Image size 2048x1536 — 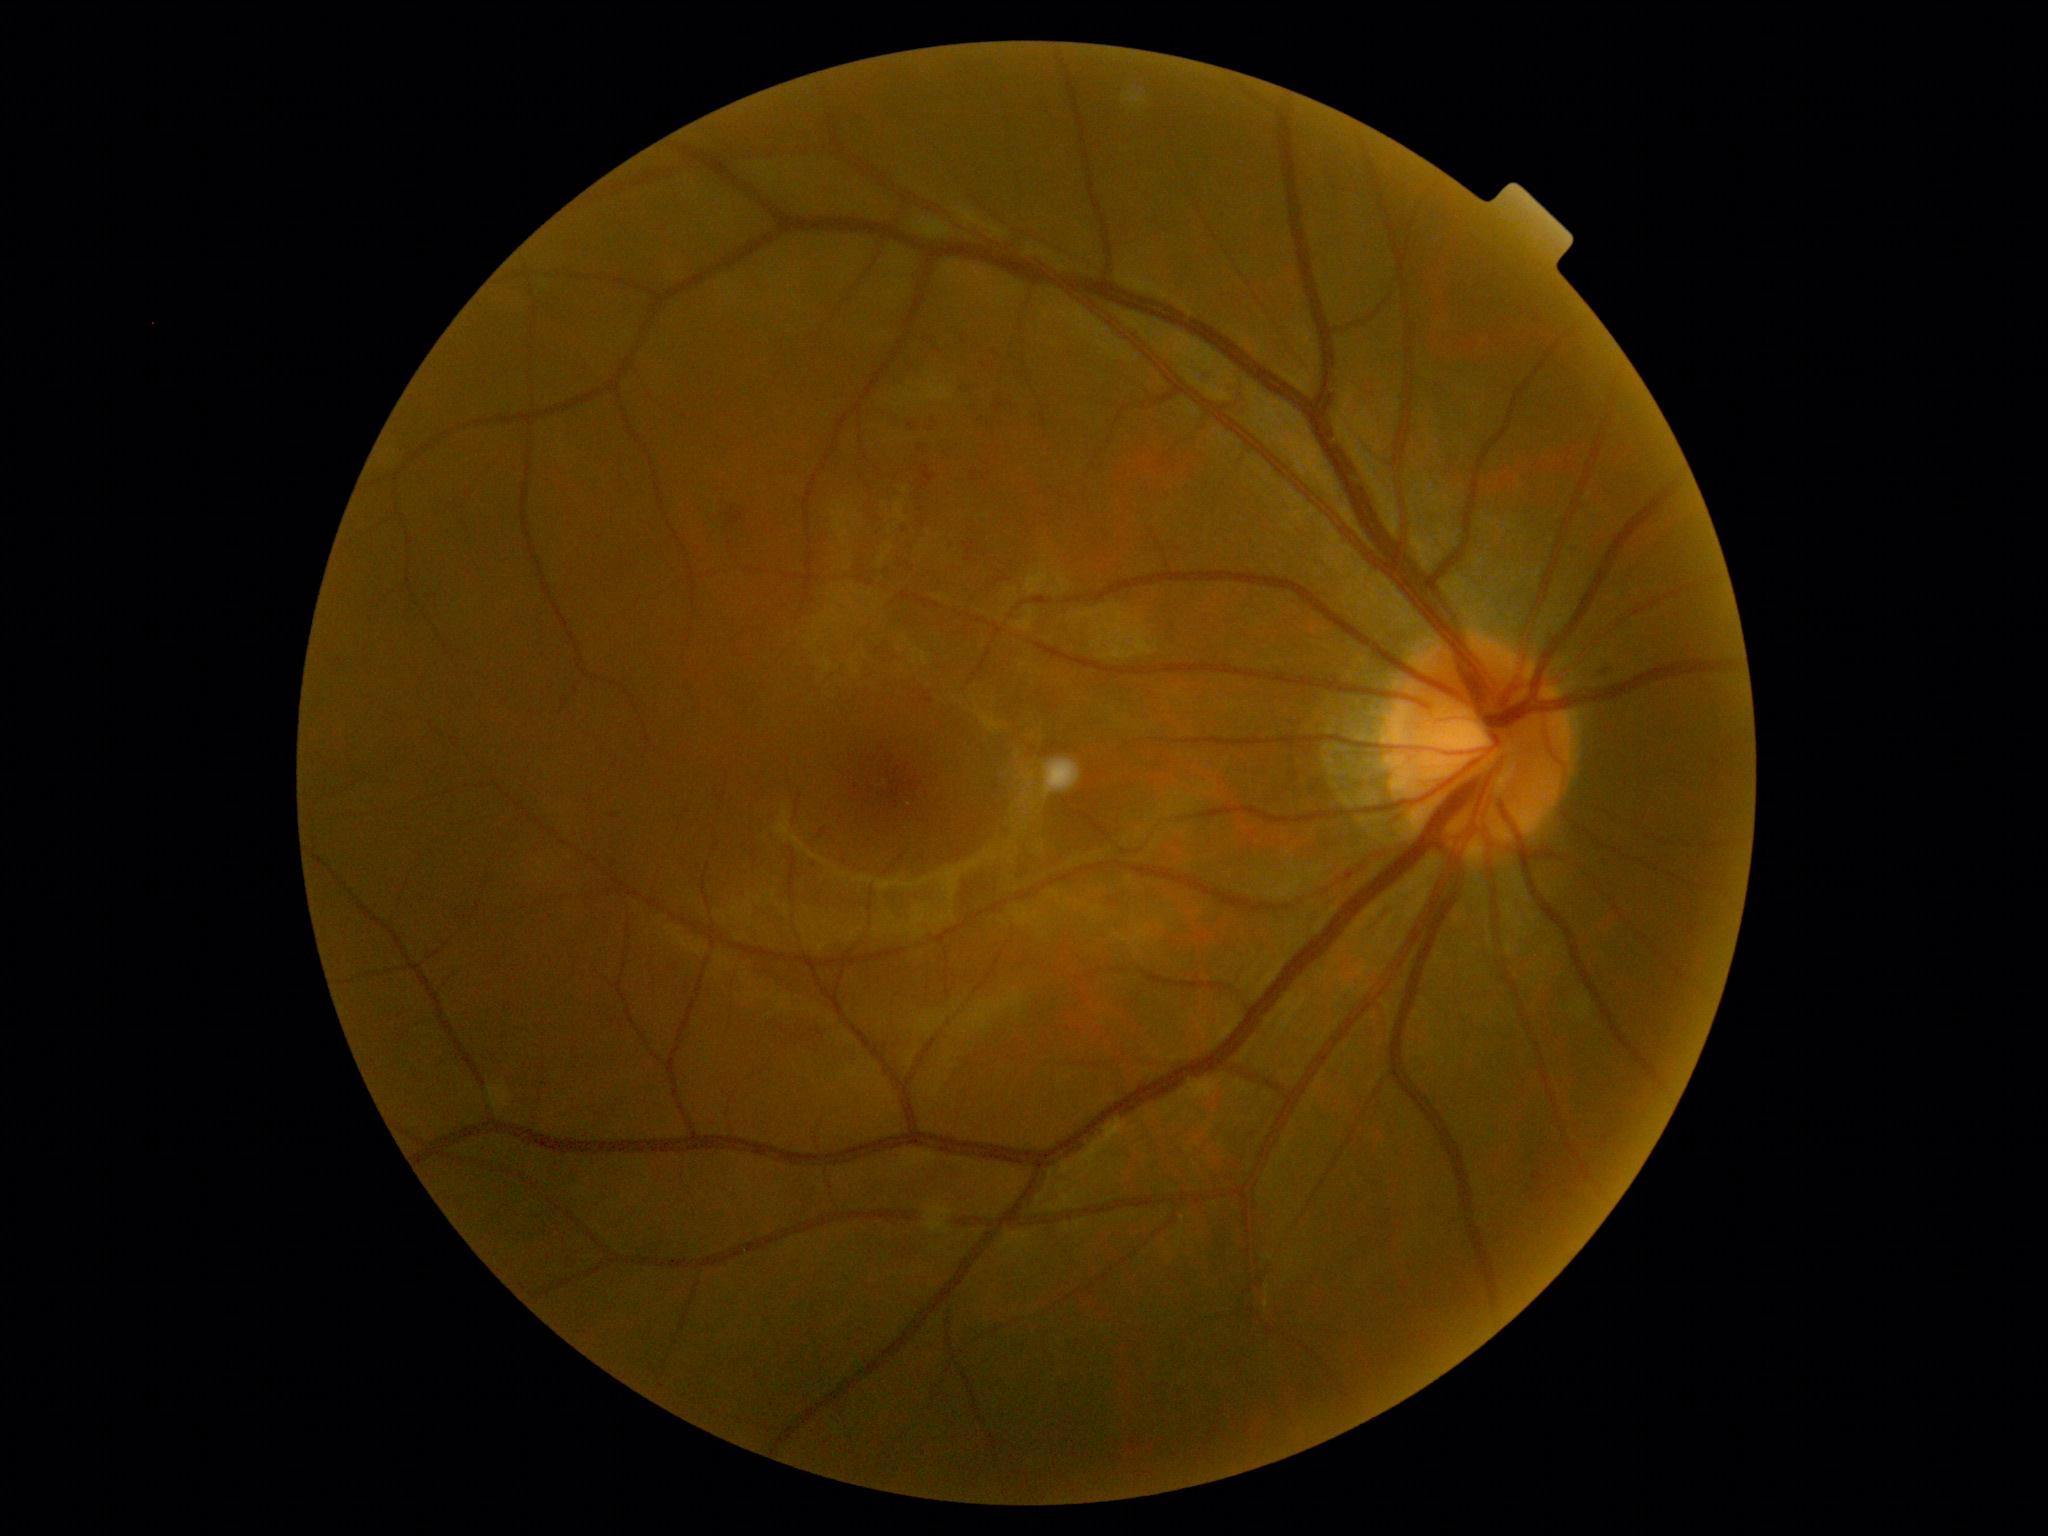
DR is grade 1.